Infant wide-field retinal image · 1240x1240
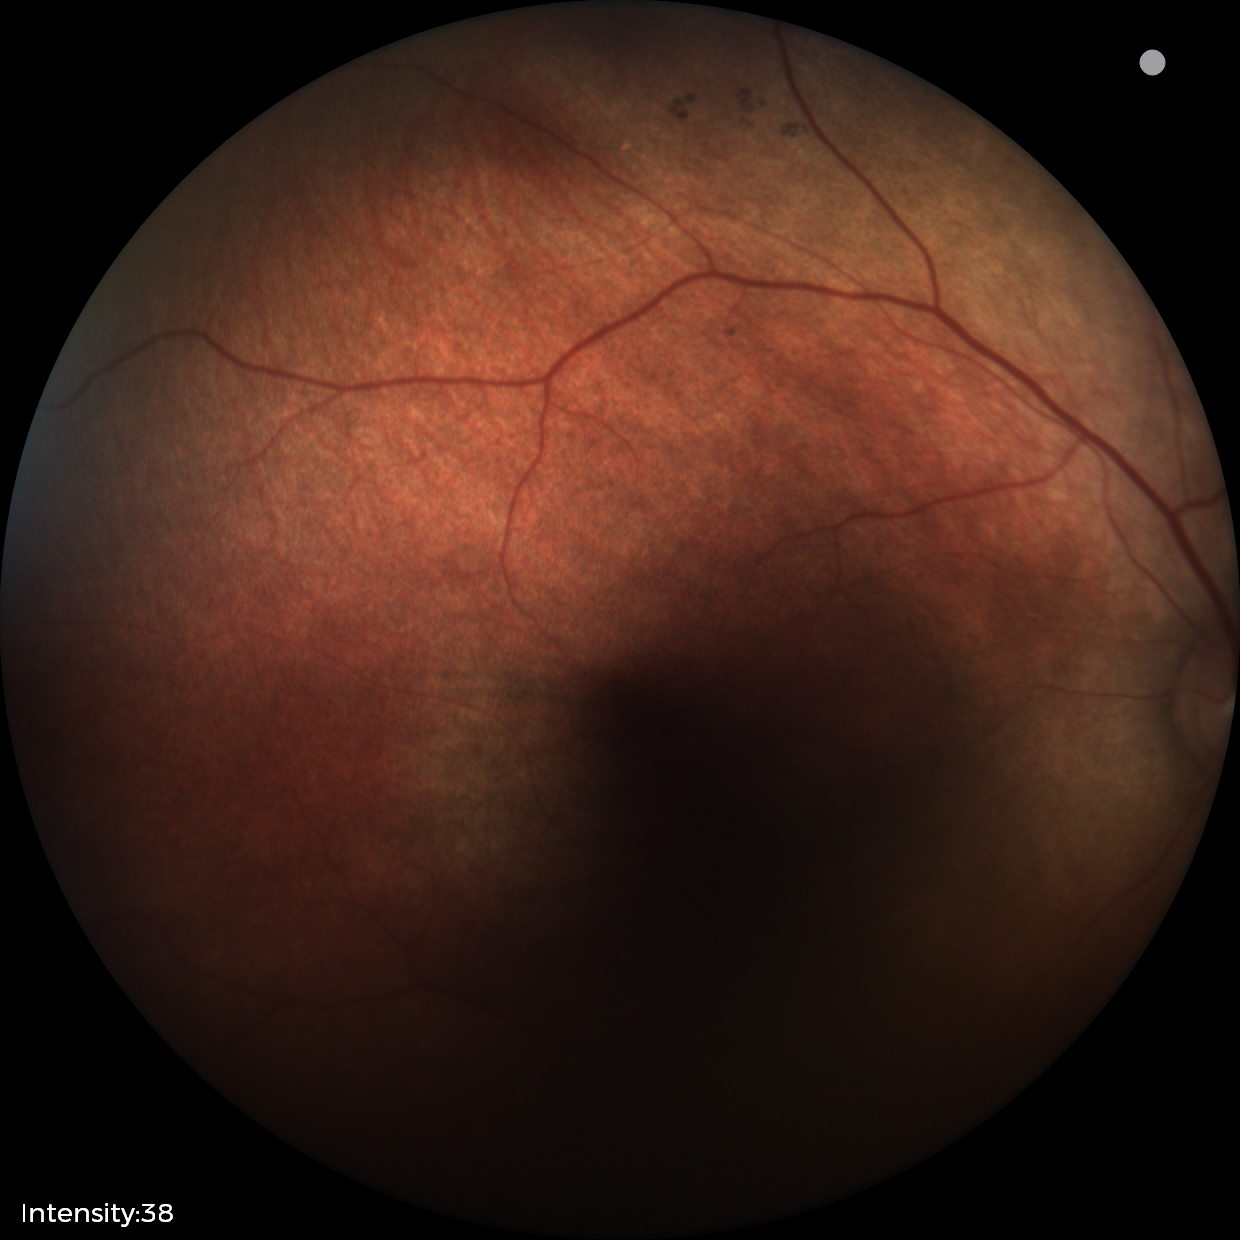
Impression: physiological appearance.